45-degree field of view:
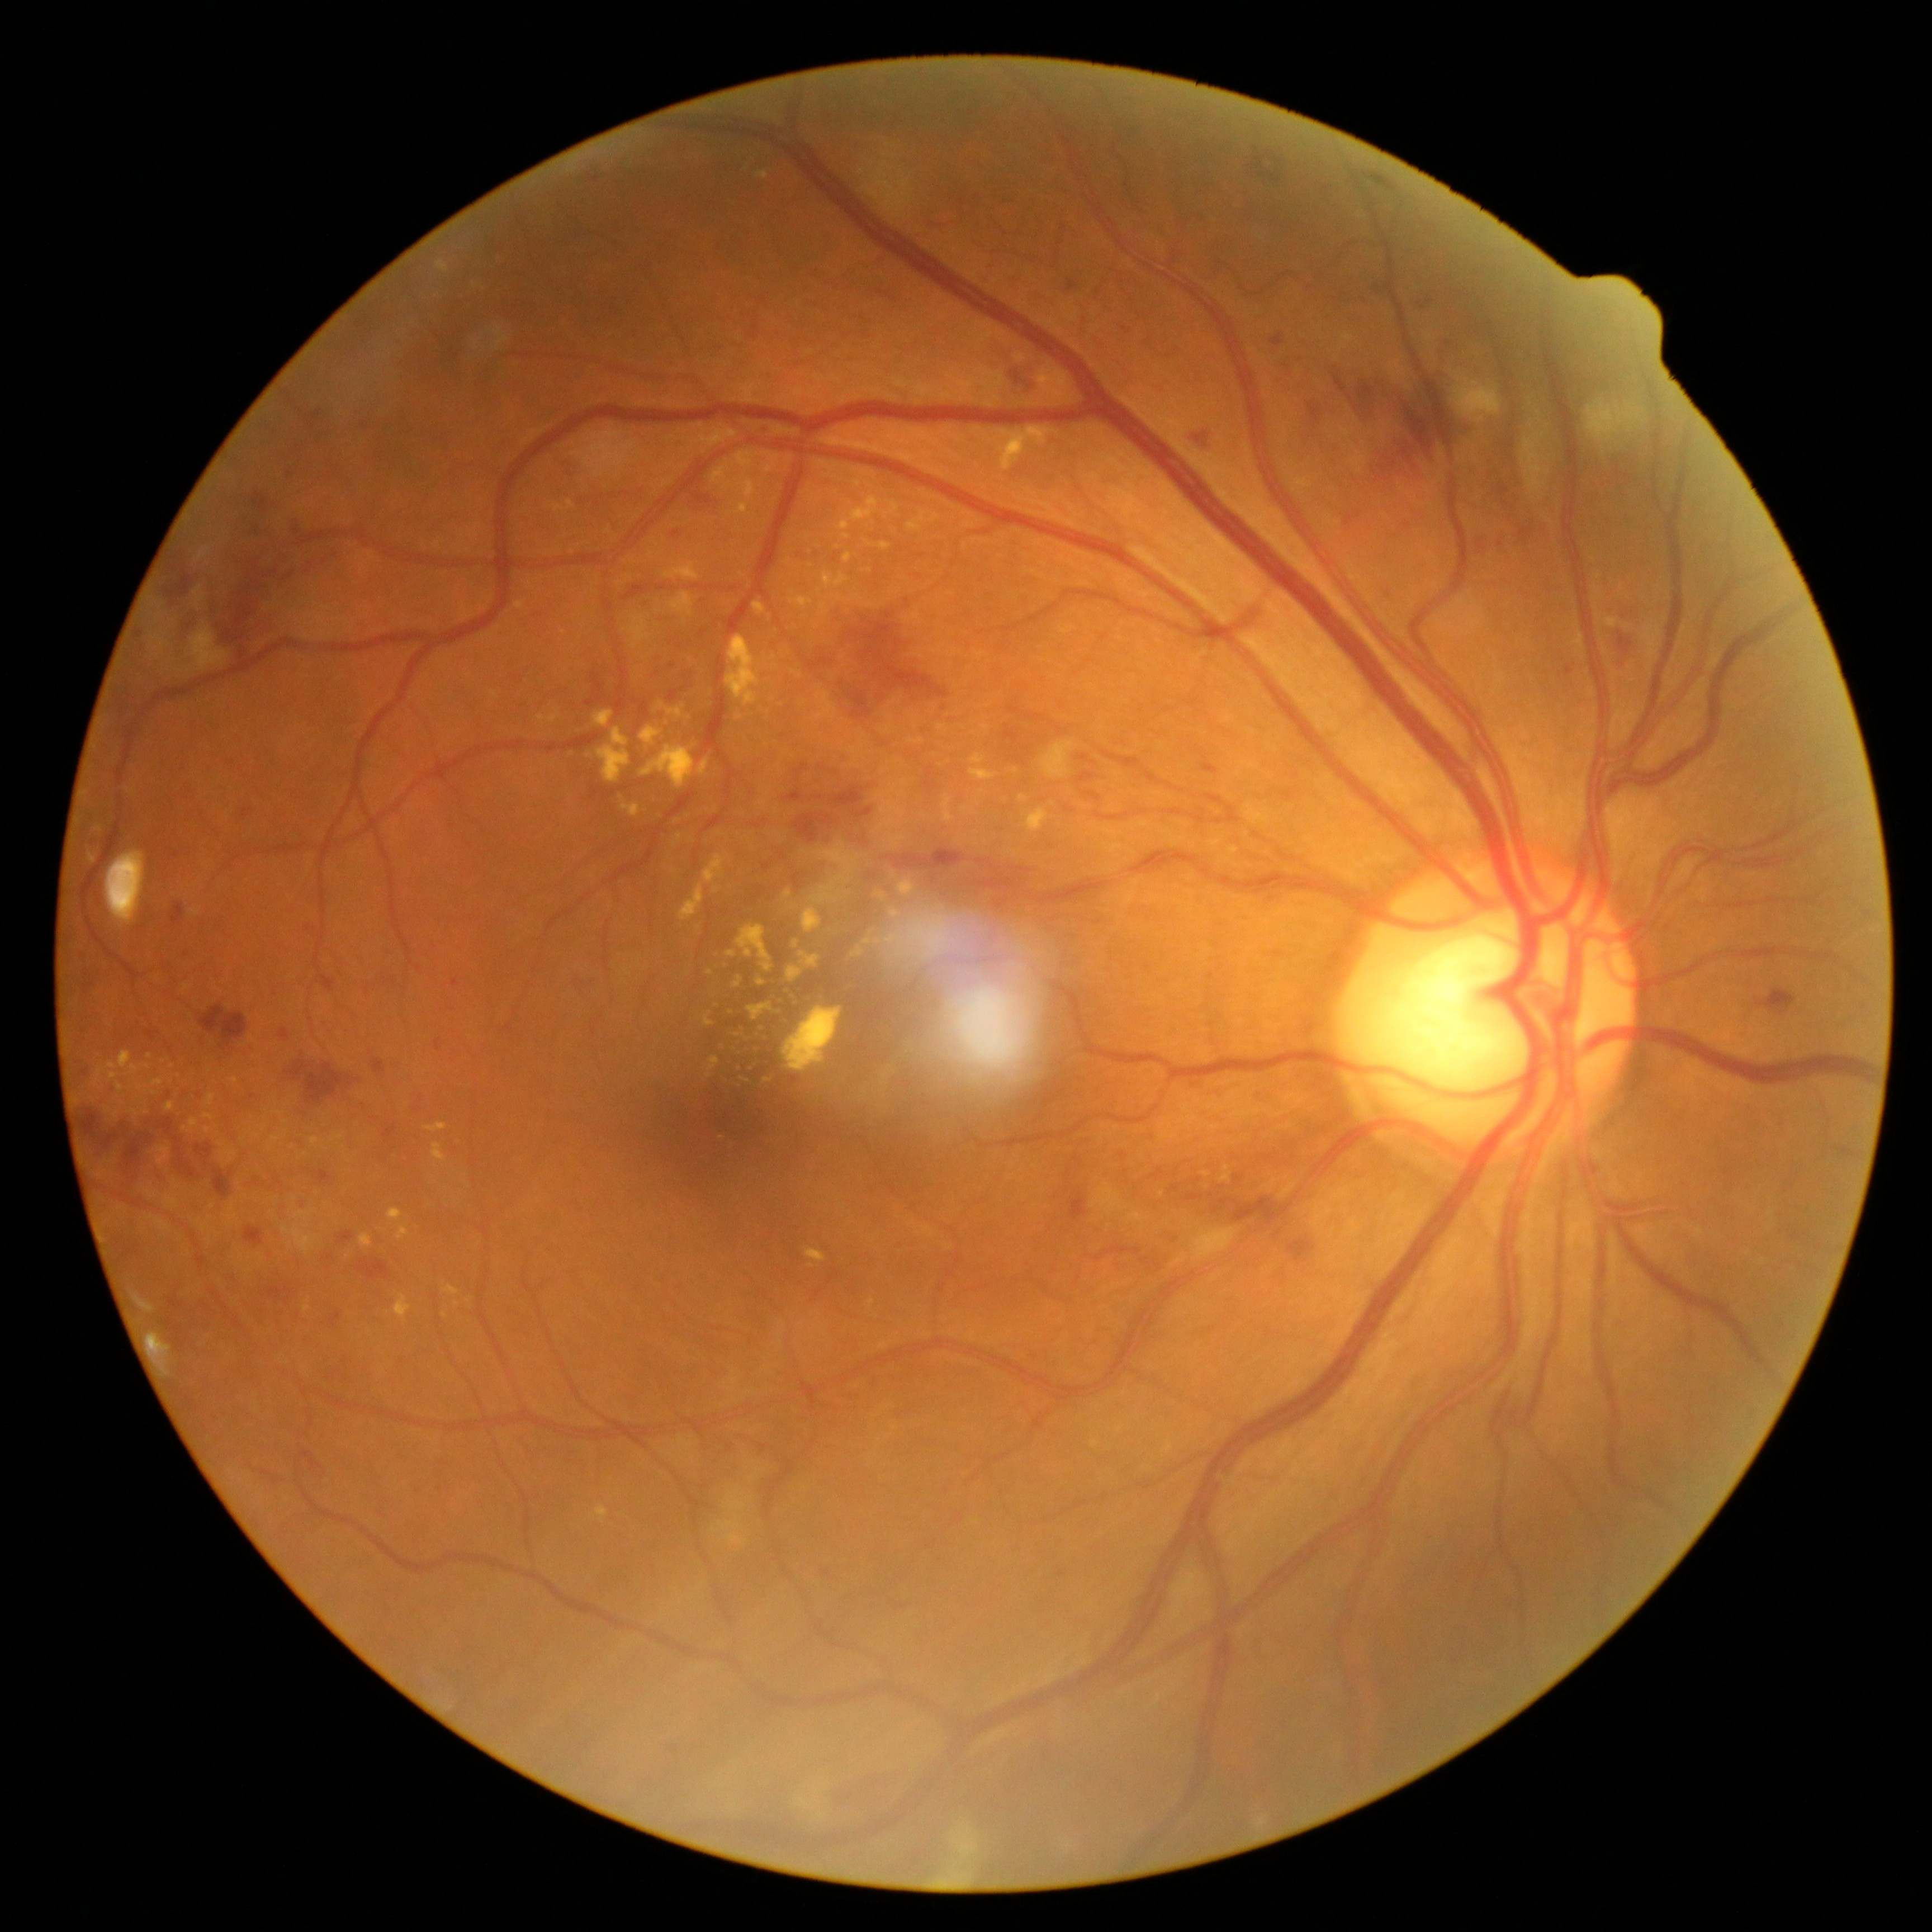

<lesions partial="true">
  <dr_grade>3</dr_grade>
  <ex partial="true">(left=396, top=1295, right=412, bottom=1322), (left=864, top=603, right=874, bottom=608), (left=736, top=504, right=749, bottom=515), (left=664, top=563, right=699, bottom=581), (left=333, top=1135, right=344, bottom=1142), (left=432, top=1144, right=447, bottom=1162), (left=754, top=603, right=766, bottom=615), (left=734, top=977, right=743, bottom=989), (left=639, top=746, right=695, bottom=790), (left=359, top=1234, right=373, bottom=1248), (left=117, top=1083, right=125, bottom=1094)</ex>
  <ex_small_approx>pt(621, 798), pt(873, 933), pt(738, 1036), pt(1015, 771), pt(710, 1076), pt(741, 1069), pt(766, 747)</ex_small_approx>
</lesions>